Fundus photo. 1468 x 1470 pixels. 45° field of view.
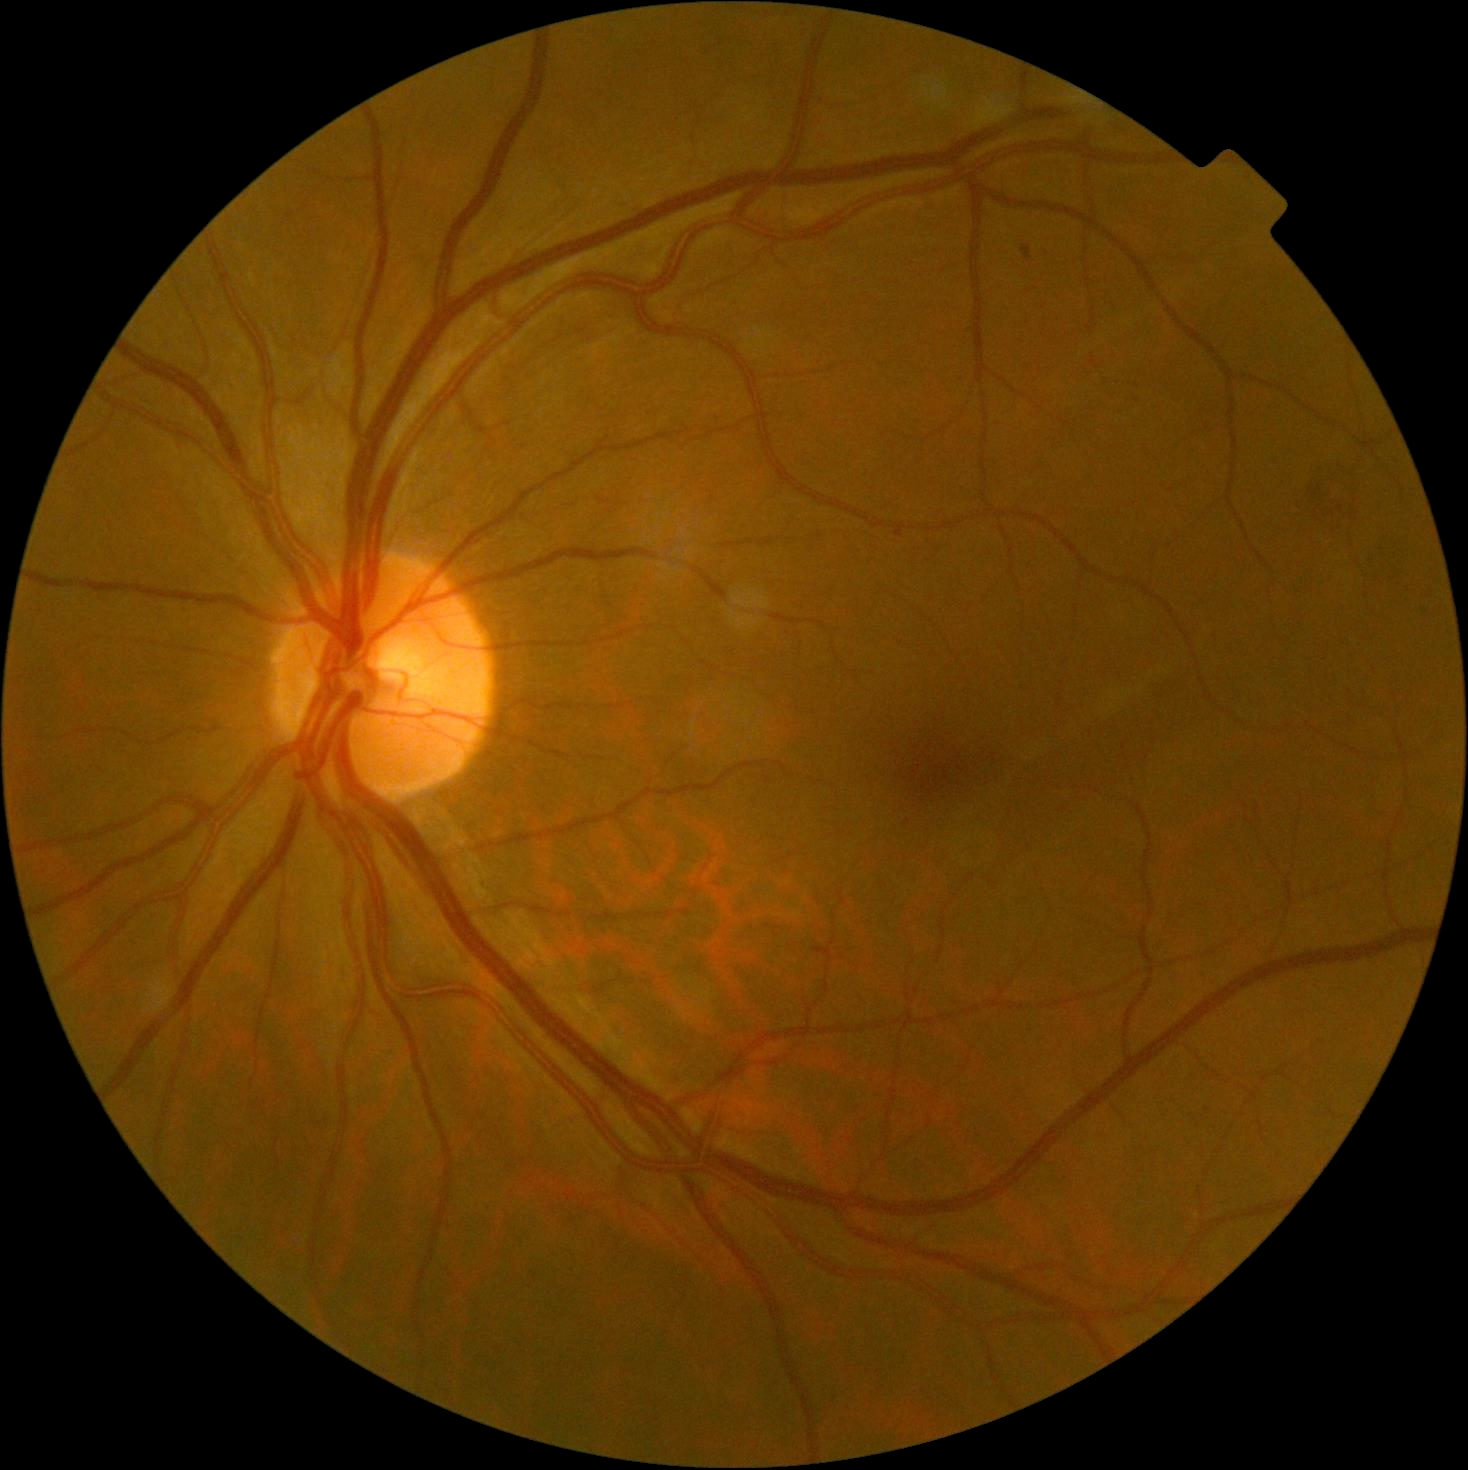
Diabetic retinopathy (DR) is moderate NPDR (grade 2) — more than just microaneurysms but less than severe NPDR.